Pediatric wide-field fundus photograph · image size 640x480 · Clarity RetCam 3, 130° FOV — 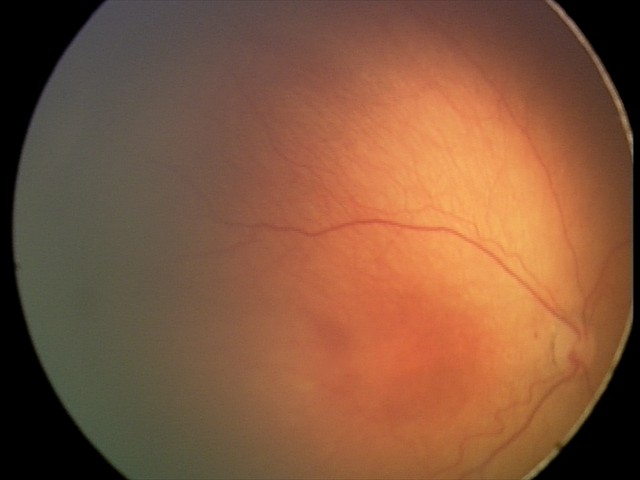
Impression: no plus disease | ROP stage 2.